Color fundus image
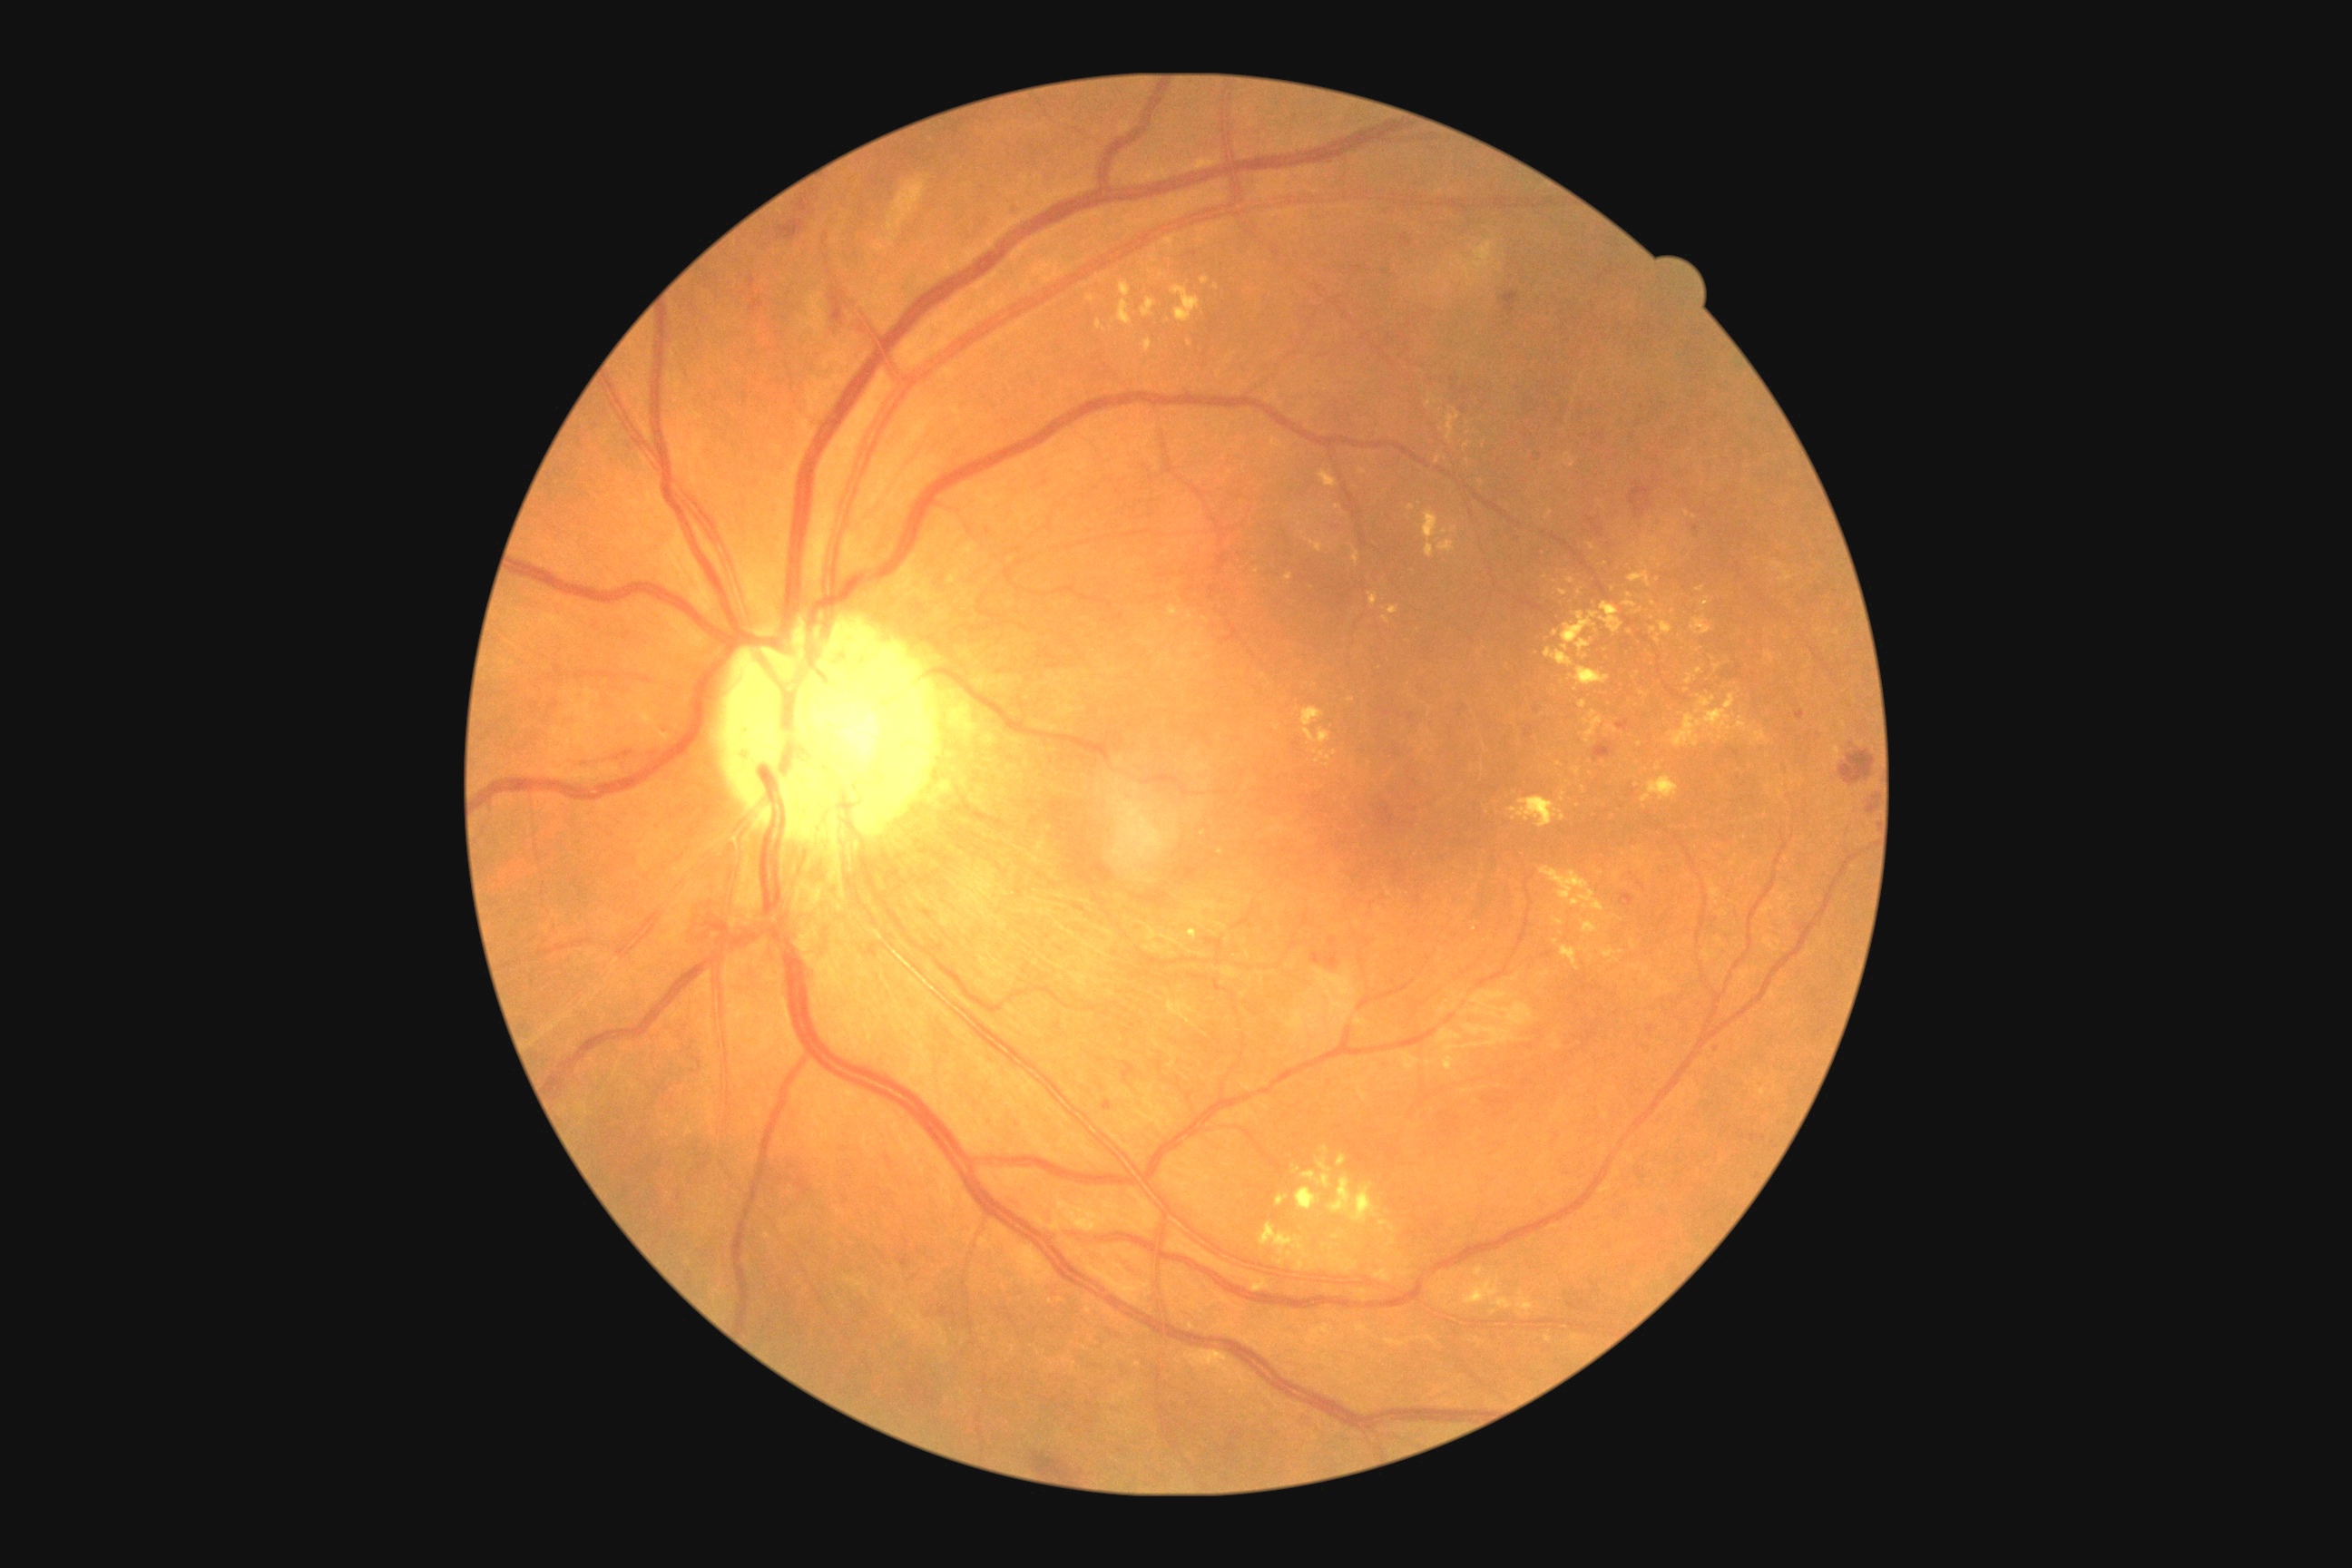 Diabetic retinopathy: grade 2 (moderate NPDR)
Representative lesions:
- microaneurysms: [1006,202,1019,213]; [1311,954,1320,963]; [1104,1101,1112,1112]; [1694,525,1700,533]; [1796,710,1805,721]
- Small microaneurysms approximately at [x=1717, y=1049]
- hemorrhages: [1631,484,1652,516]; [1594,741,1614,761]; [1839,750,1876,787]; [1329,939,1337,946]; [1587,516,1605,538]; [1326,956,1340,970]; [776,220,805,242]; [1400,235,1413,248]; [1500,293,1520,317]; [1867,805,1876,816]; [1620,894,1634,906]; [750,299,765,317]; [1618,721,1629,730]; [1525,727,1533,738]; [574,750,629,763]; [1311,954,1322,965]; [830,289,848,326]
- Small hemorrhages approximately at [x=1537, y=711]
- soft exudates: none detected
- hard exudates (subset): [1631,965,1642,970]; [1320,750,1331,761]; [1669,694,1736,749]; [1311,540,1324,553]; [1540,970,1551,979]; [1516,1291,1534,1311]; [1297,1188,1322,1211]; [1558,589,1569,596]; [1752,730,1769,745]; [1190,930,1197,939]; [1171,286,1202,324]
- Small hard exudates approximately at [x=1655, y=560]; [x=1469, y=434]; [x=1694, y=518]; [x=1467, y=445]; [x=1228, y=363]; [x=1219, y=374]; [x=1445, y=531]; [x=1189, y=345]; [x=1640, y=865]